Retinal fundus photograph — 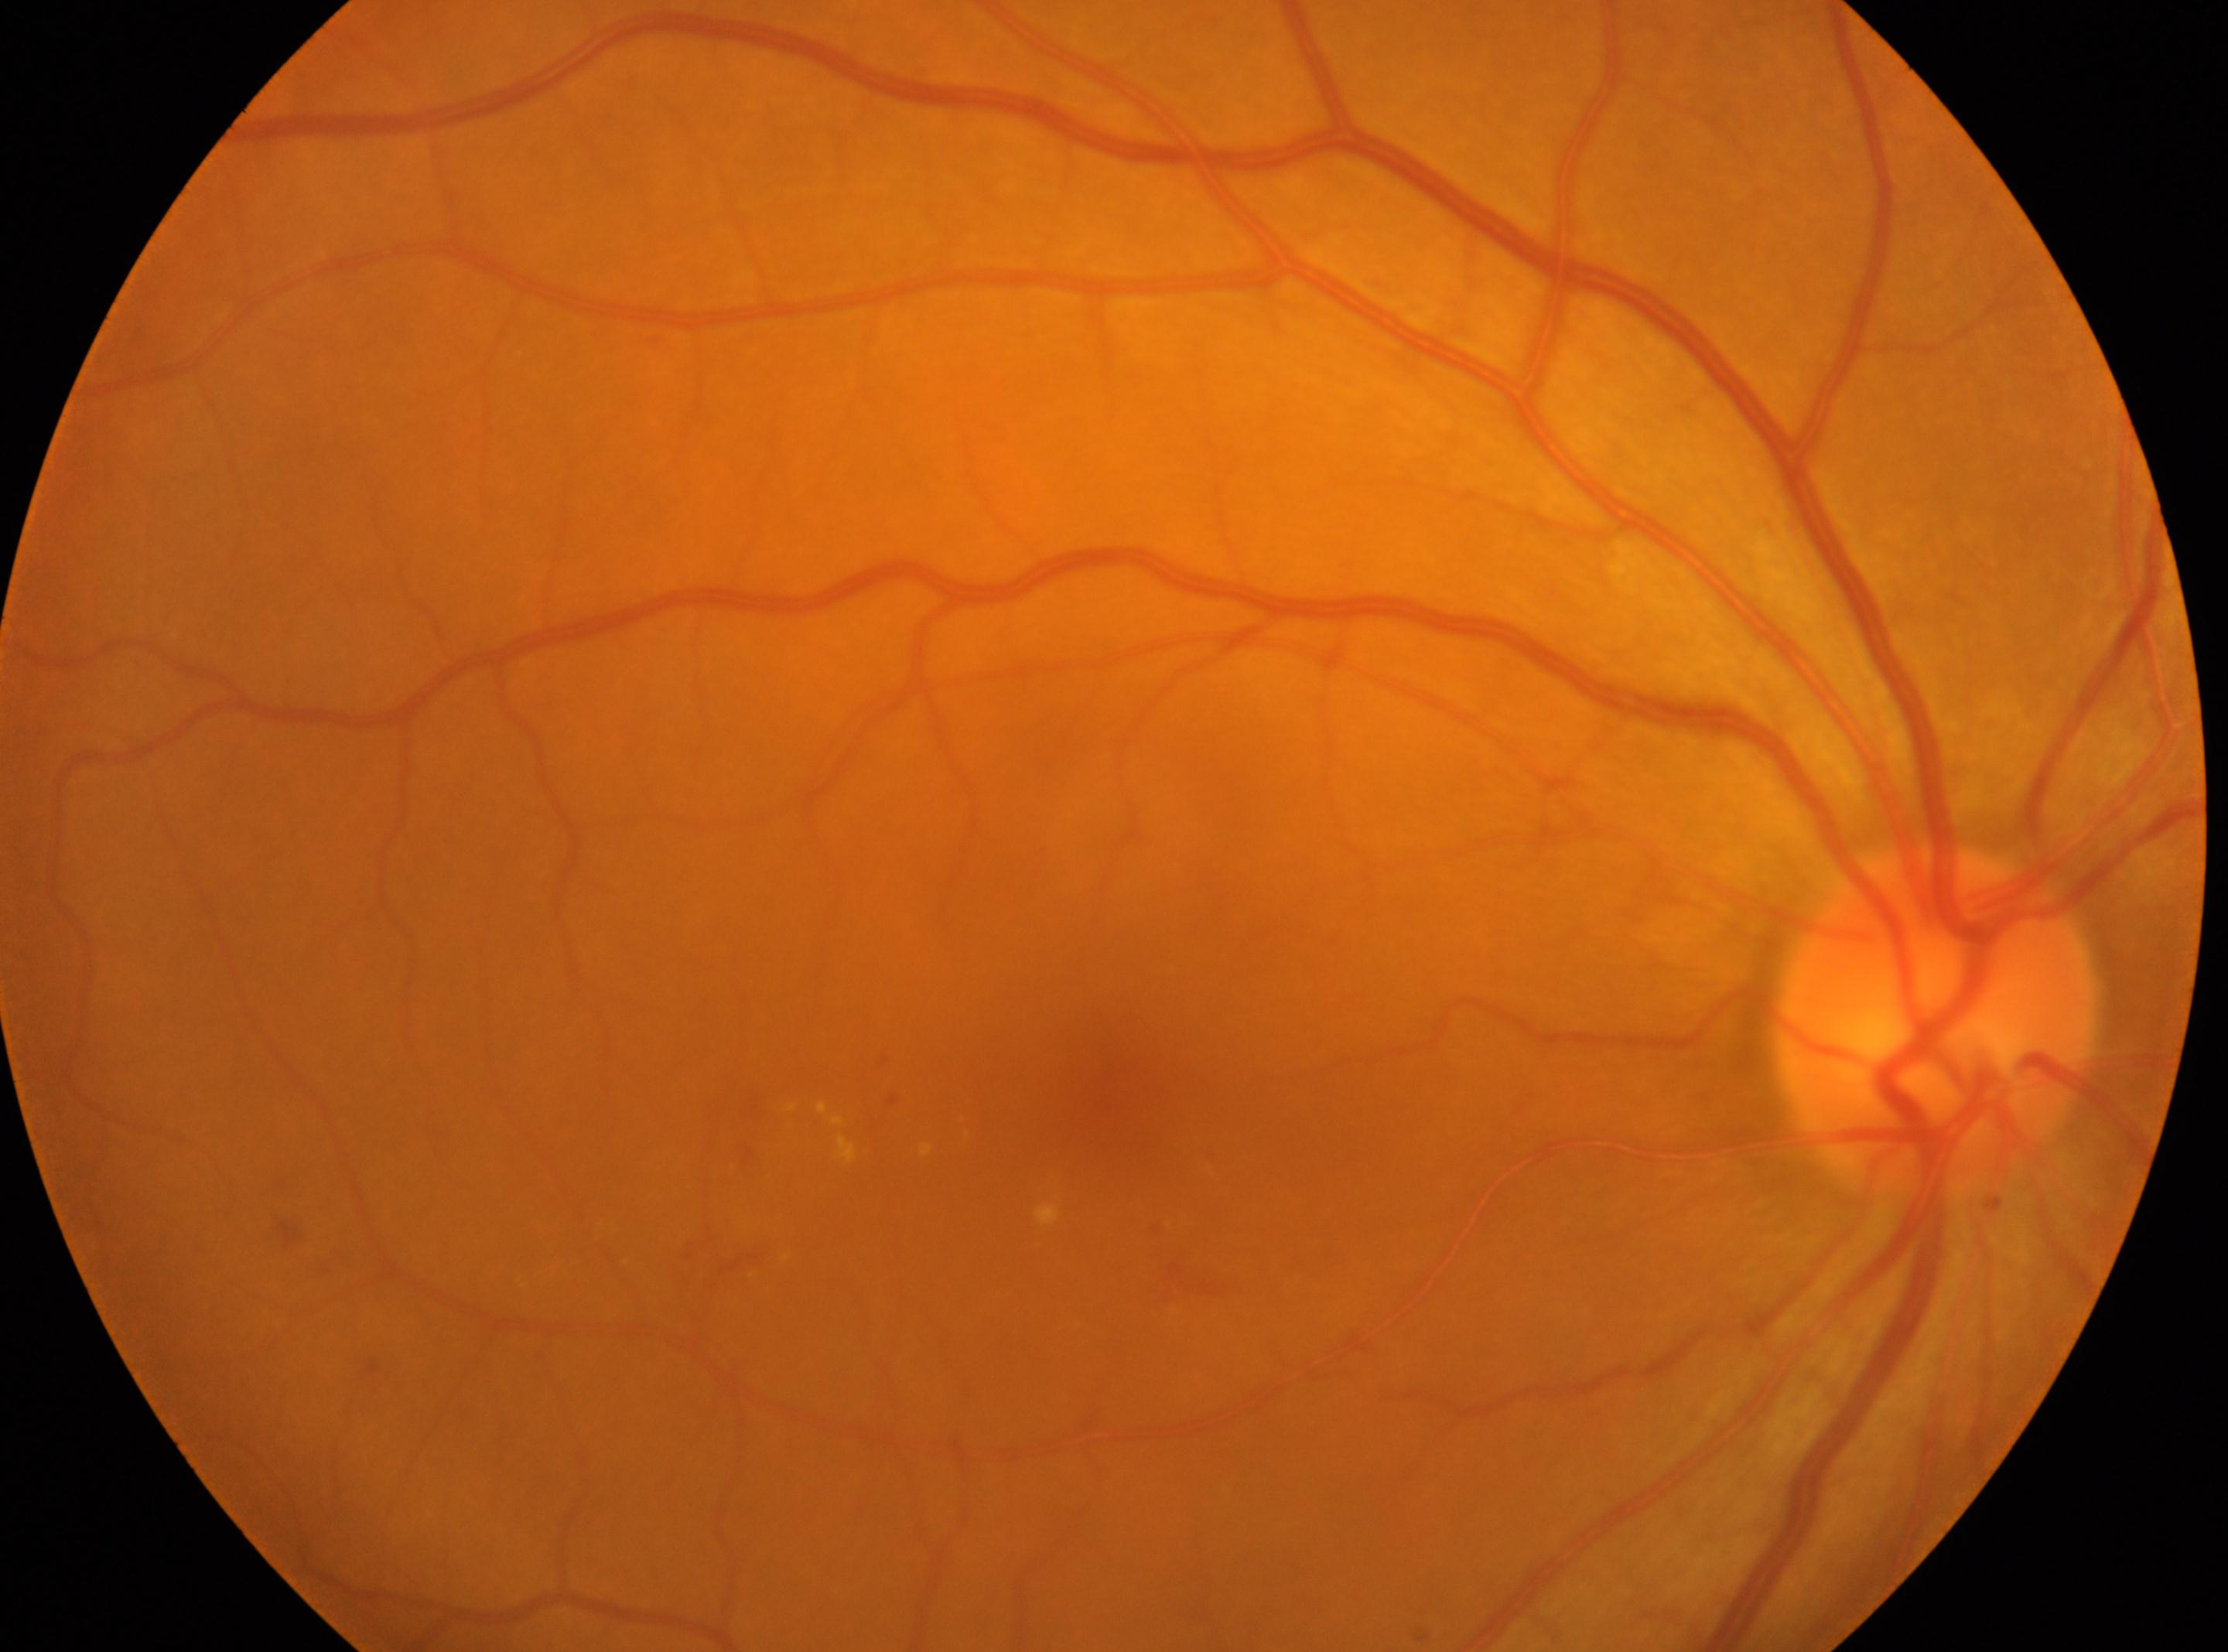

eye = OD
fovea = (1109, 1100)
diabetic retinopathy (DR) = grade 2 (moderate NPDR)
optic nerve head = (1936, 1018)